45-degree field of view, retinal fundus photograph, 2352 by 1568 pixels — 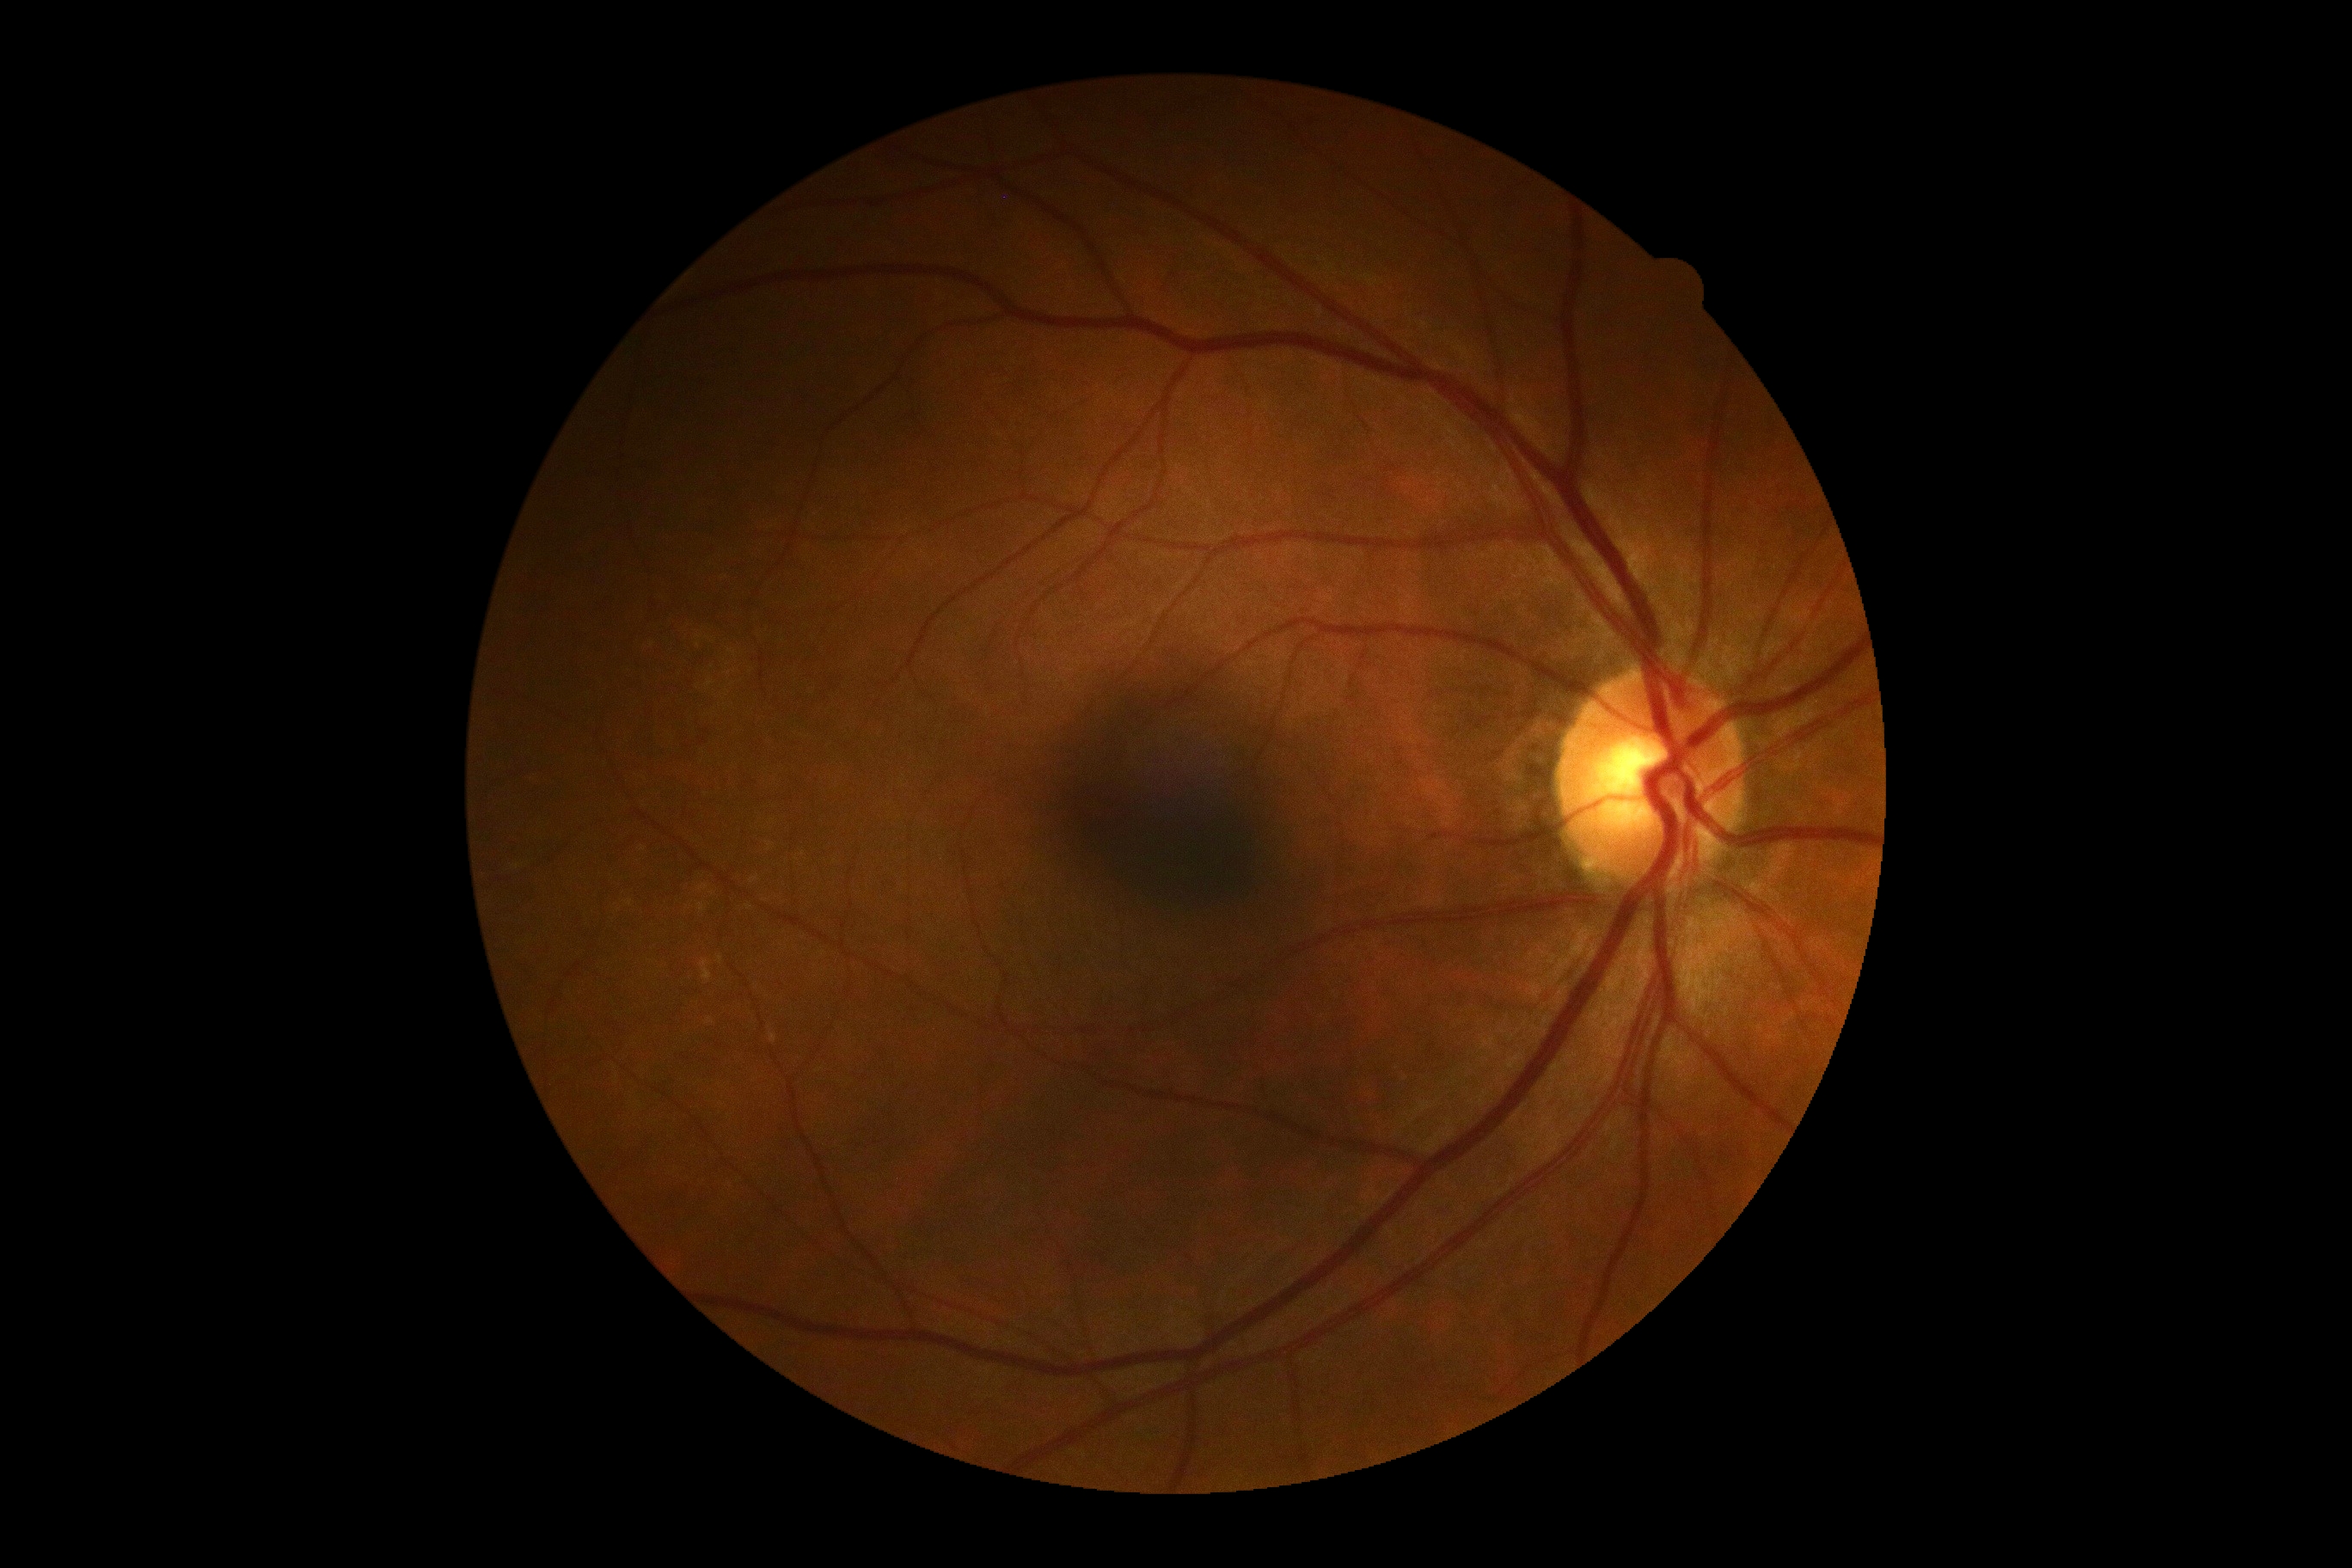 Annotations:
– DR grade: no apparent retinopathy (0)
– DR impression: no signs of DR